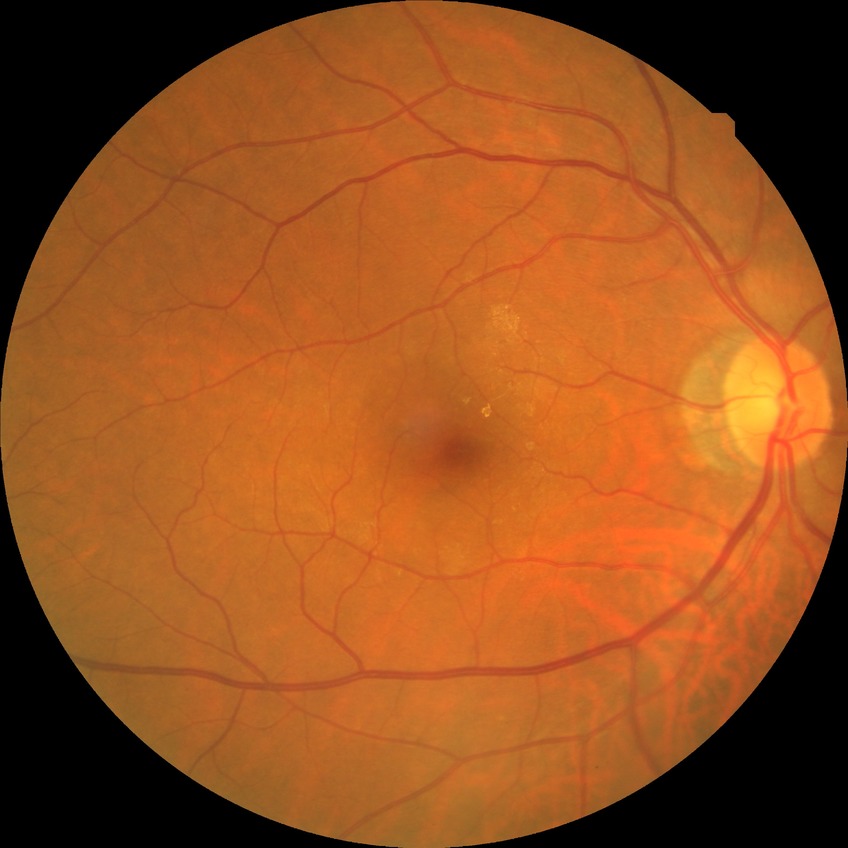

Diabetic retinopathy (DR) is no diabetic retinopathy (NDR).